Field includes the optic disc and macula, retinal fundus photograph, pupil-dilated, 2228x1652
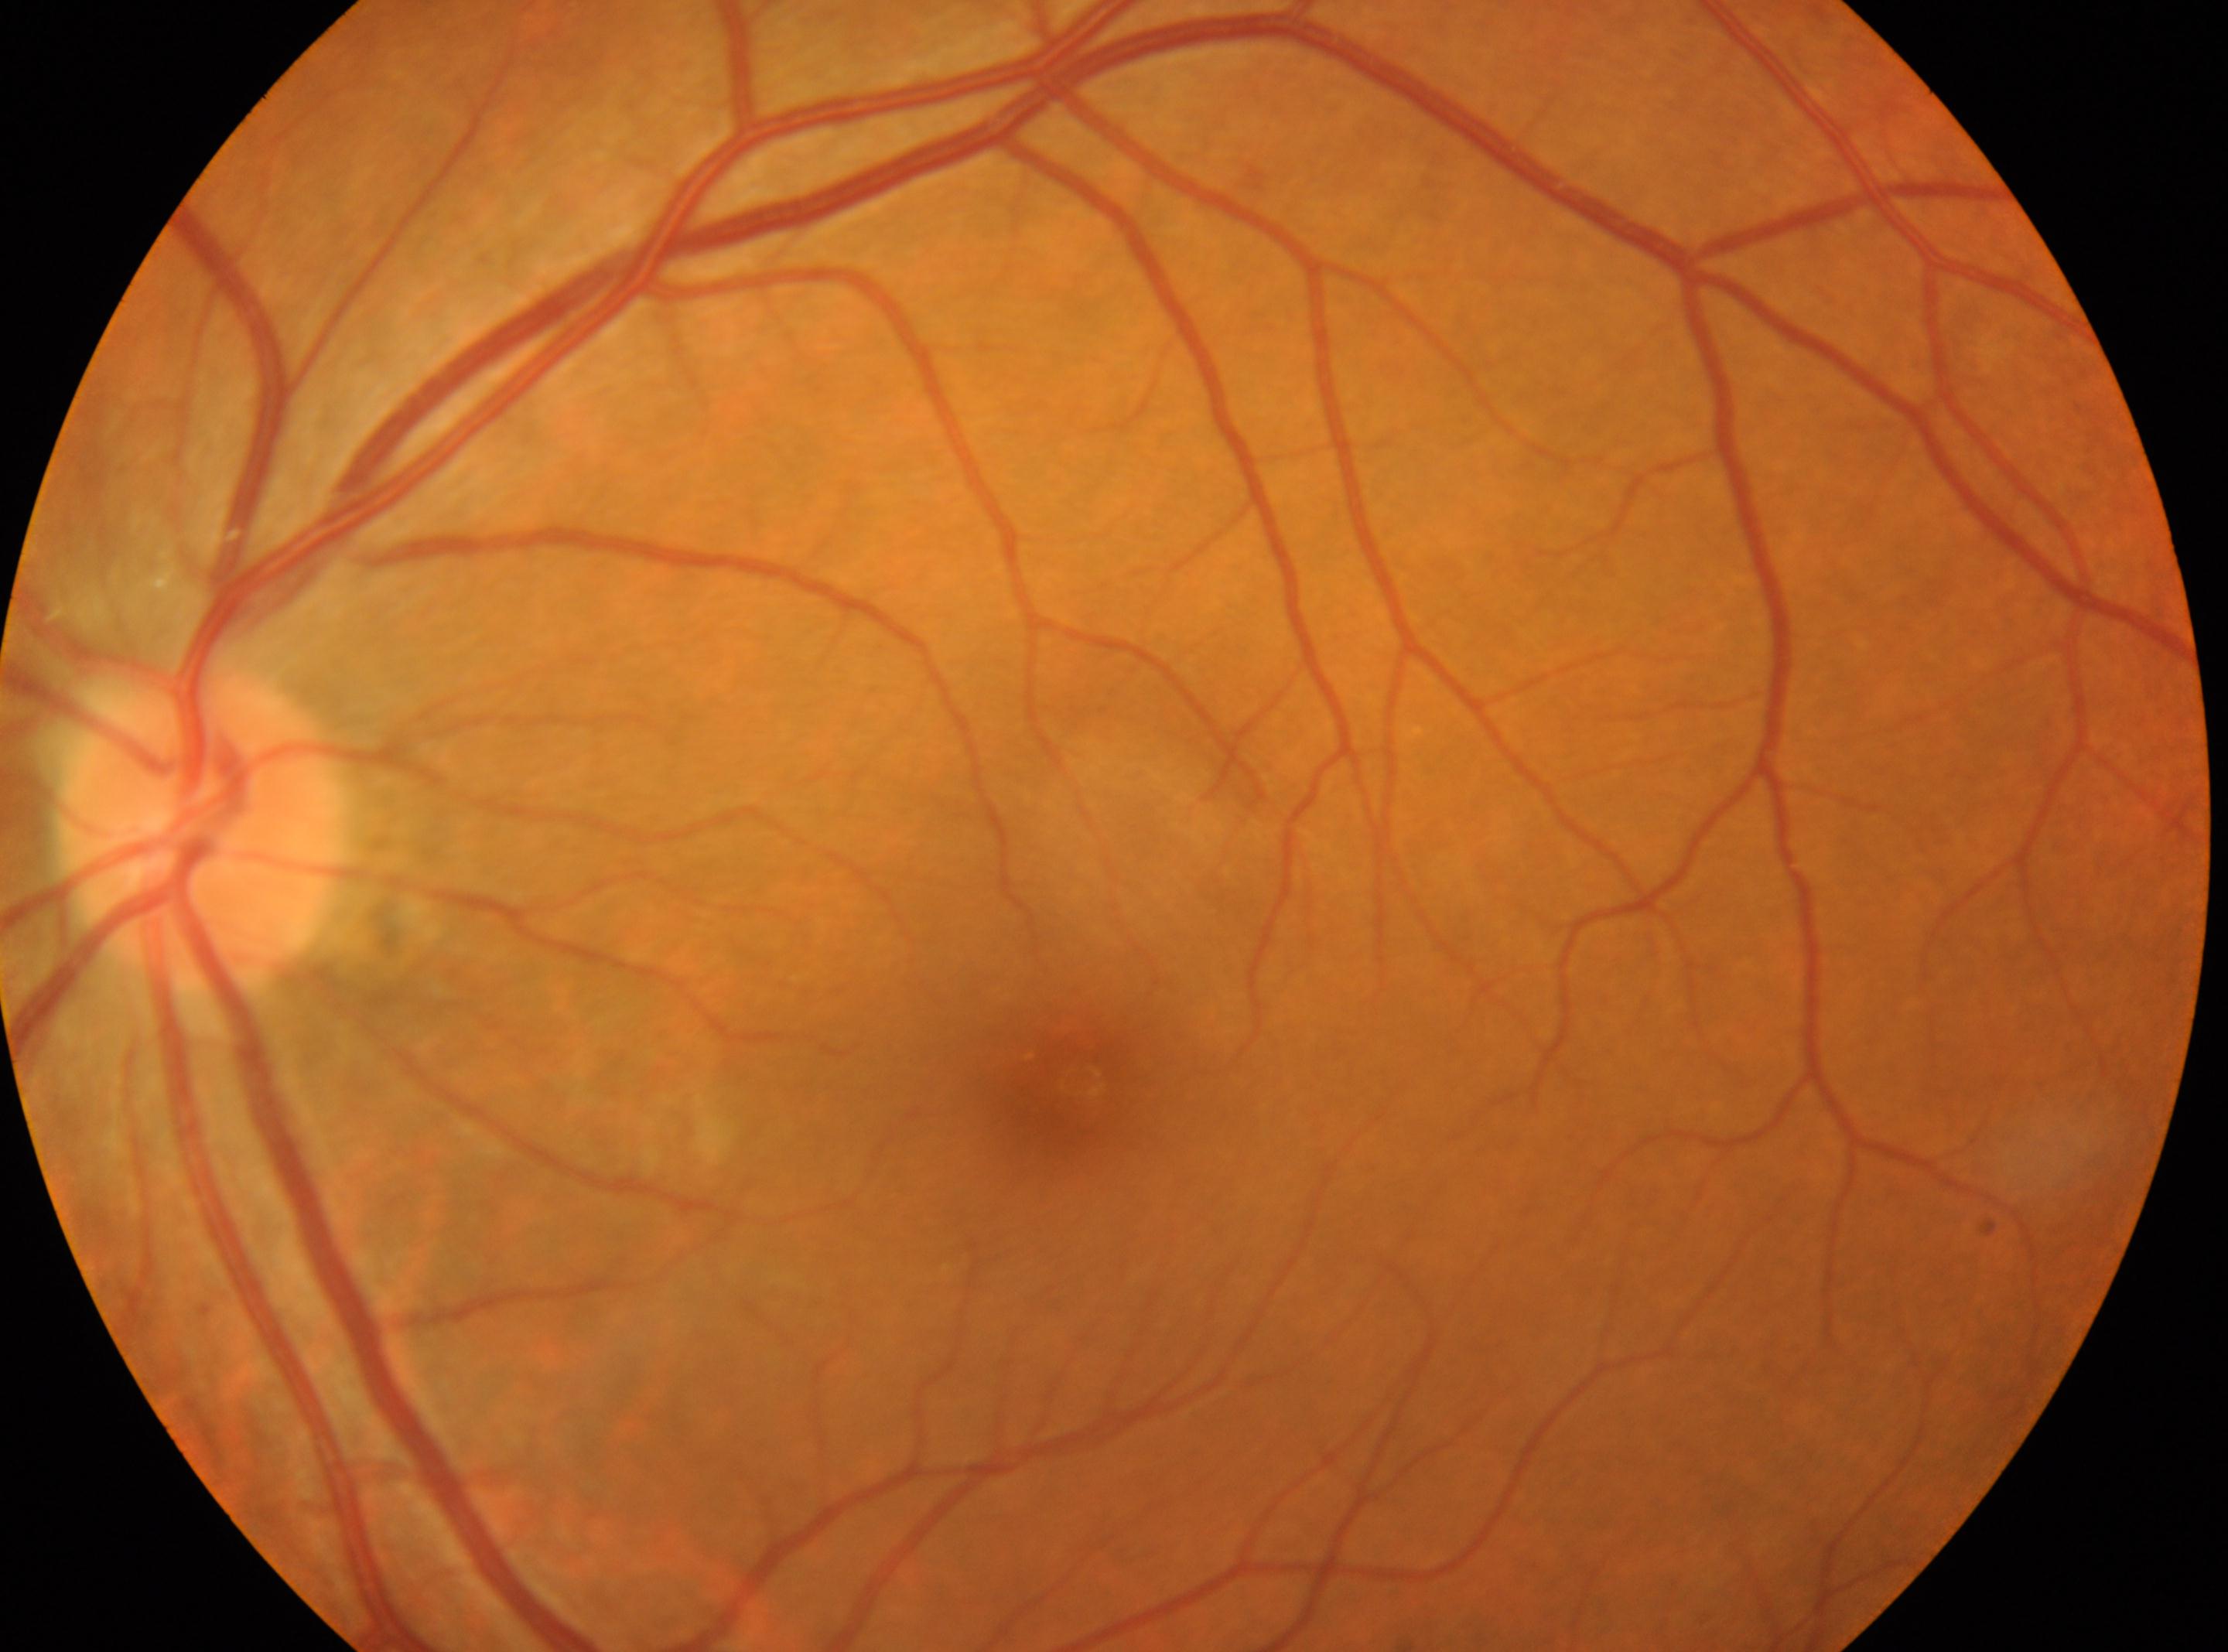 fovea centralis = [1083, 1083]; laterality = left eye; DR = grade 0 (no apparent retinopathy); ONH = [200, 831].